1240 by 1240 pixels · camera: Phoenix ICON (100° FOV) · pediatric retinal photograph (wide-field).
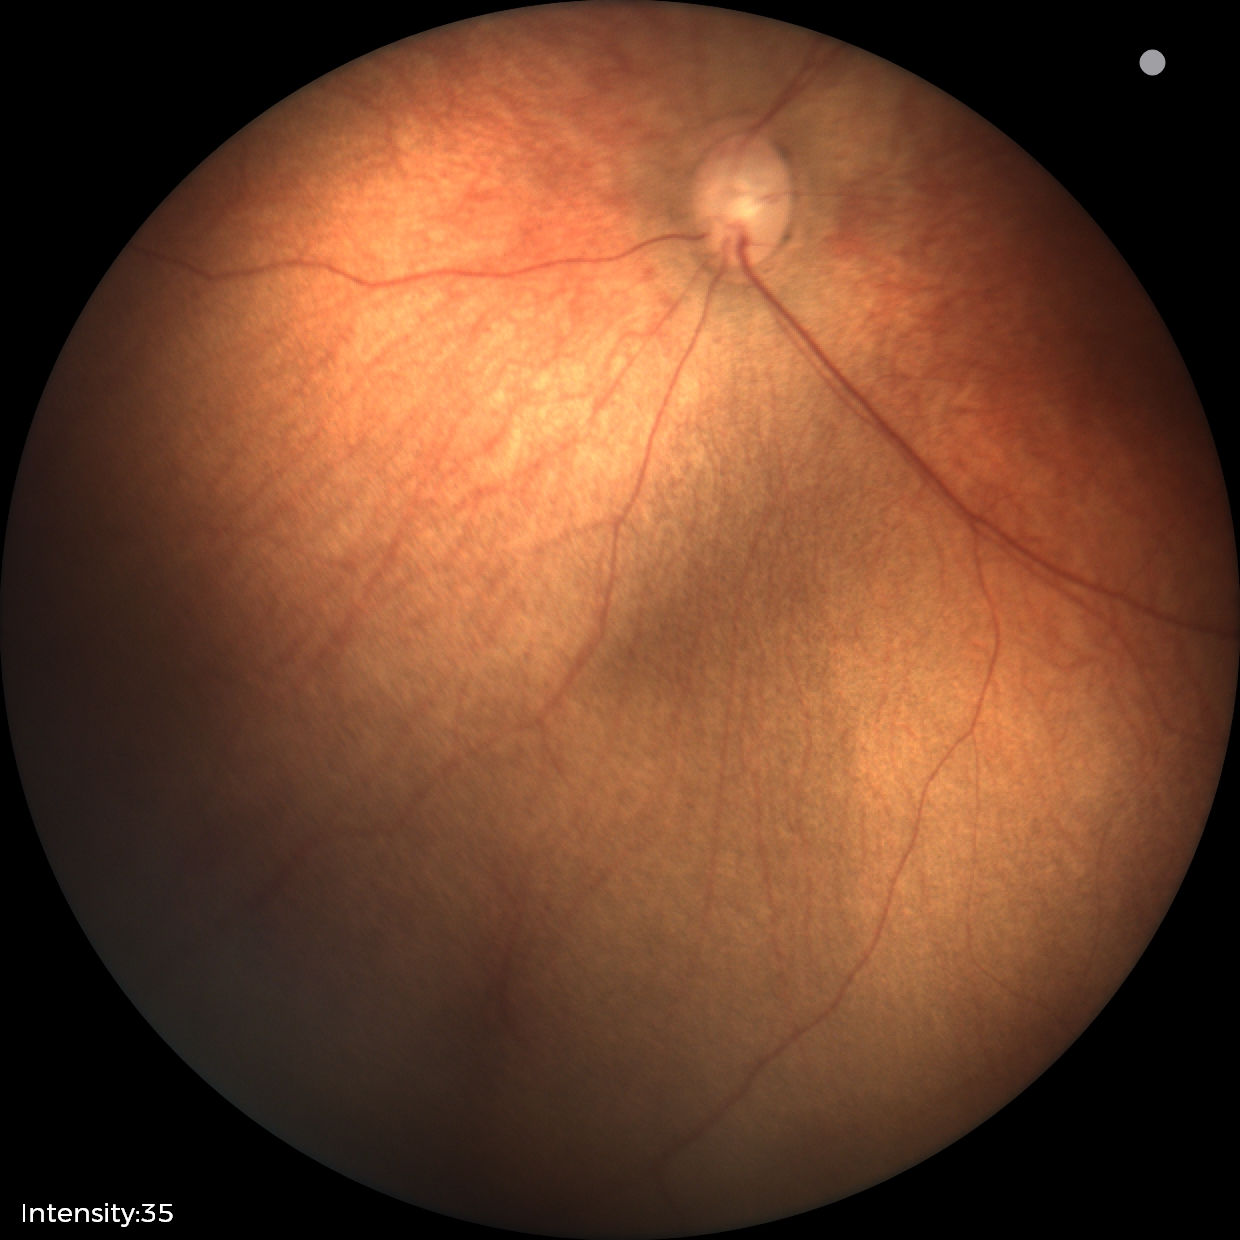
Examination with physiological retinal findings.